Acquired with a Nidek AFC-330:
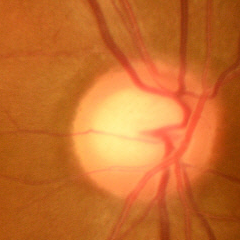 Color fundus photograph showing no evidence of glaucoma.